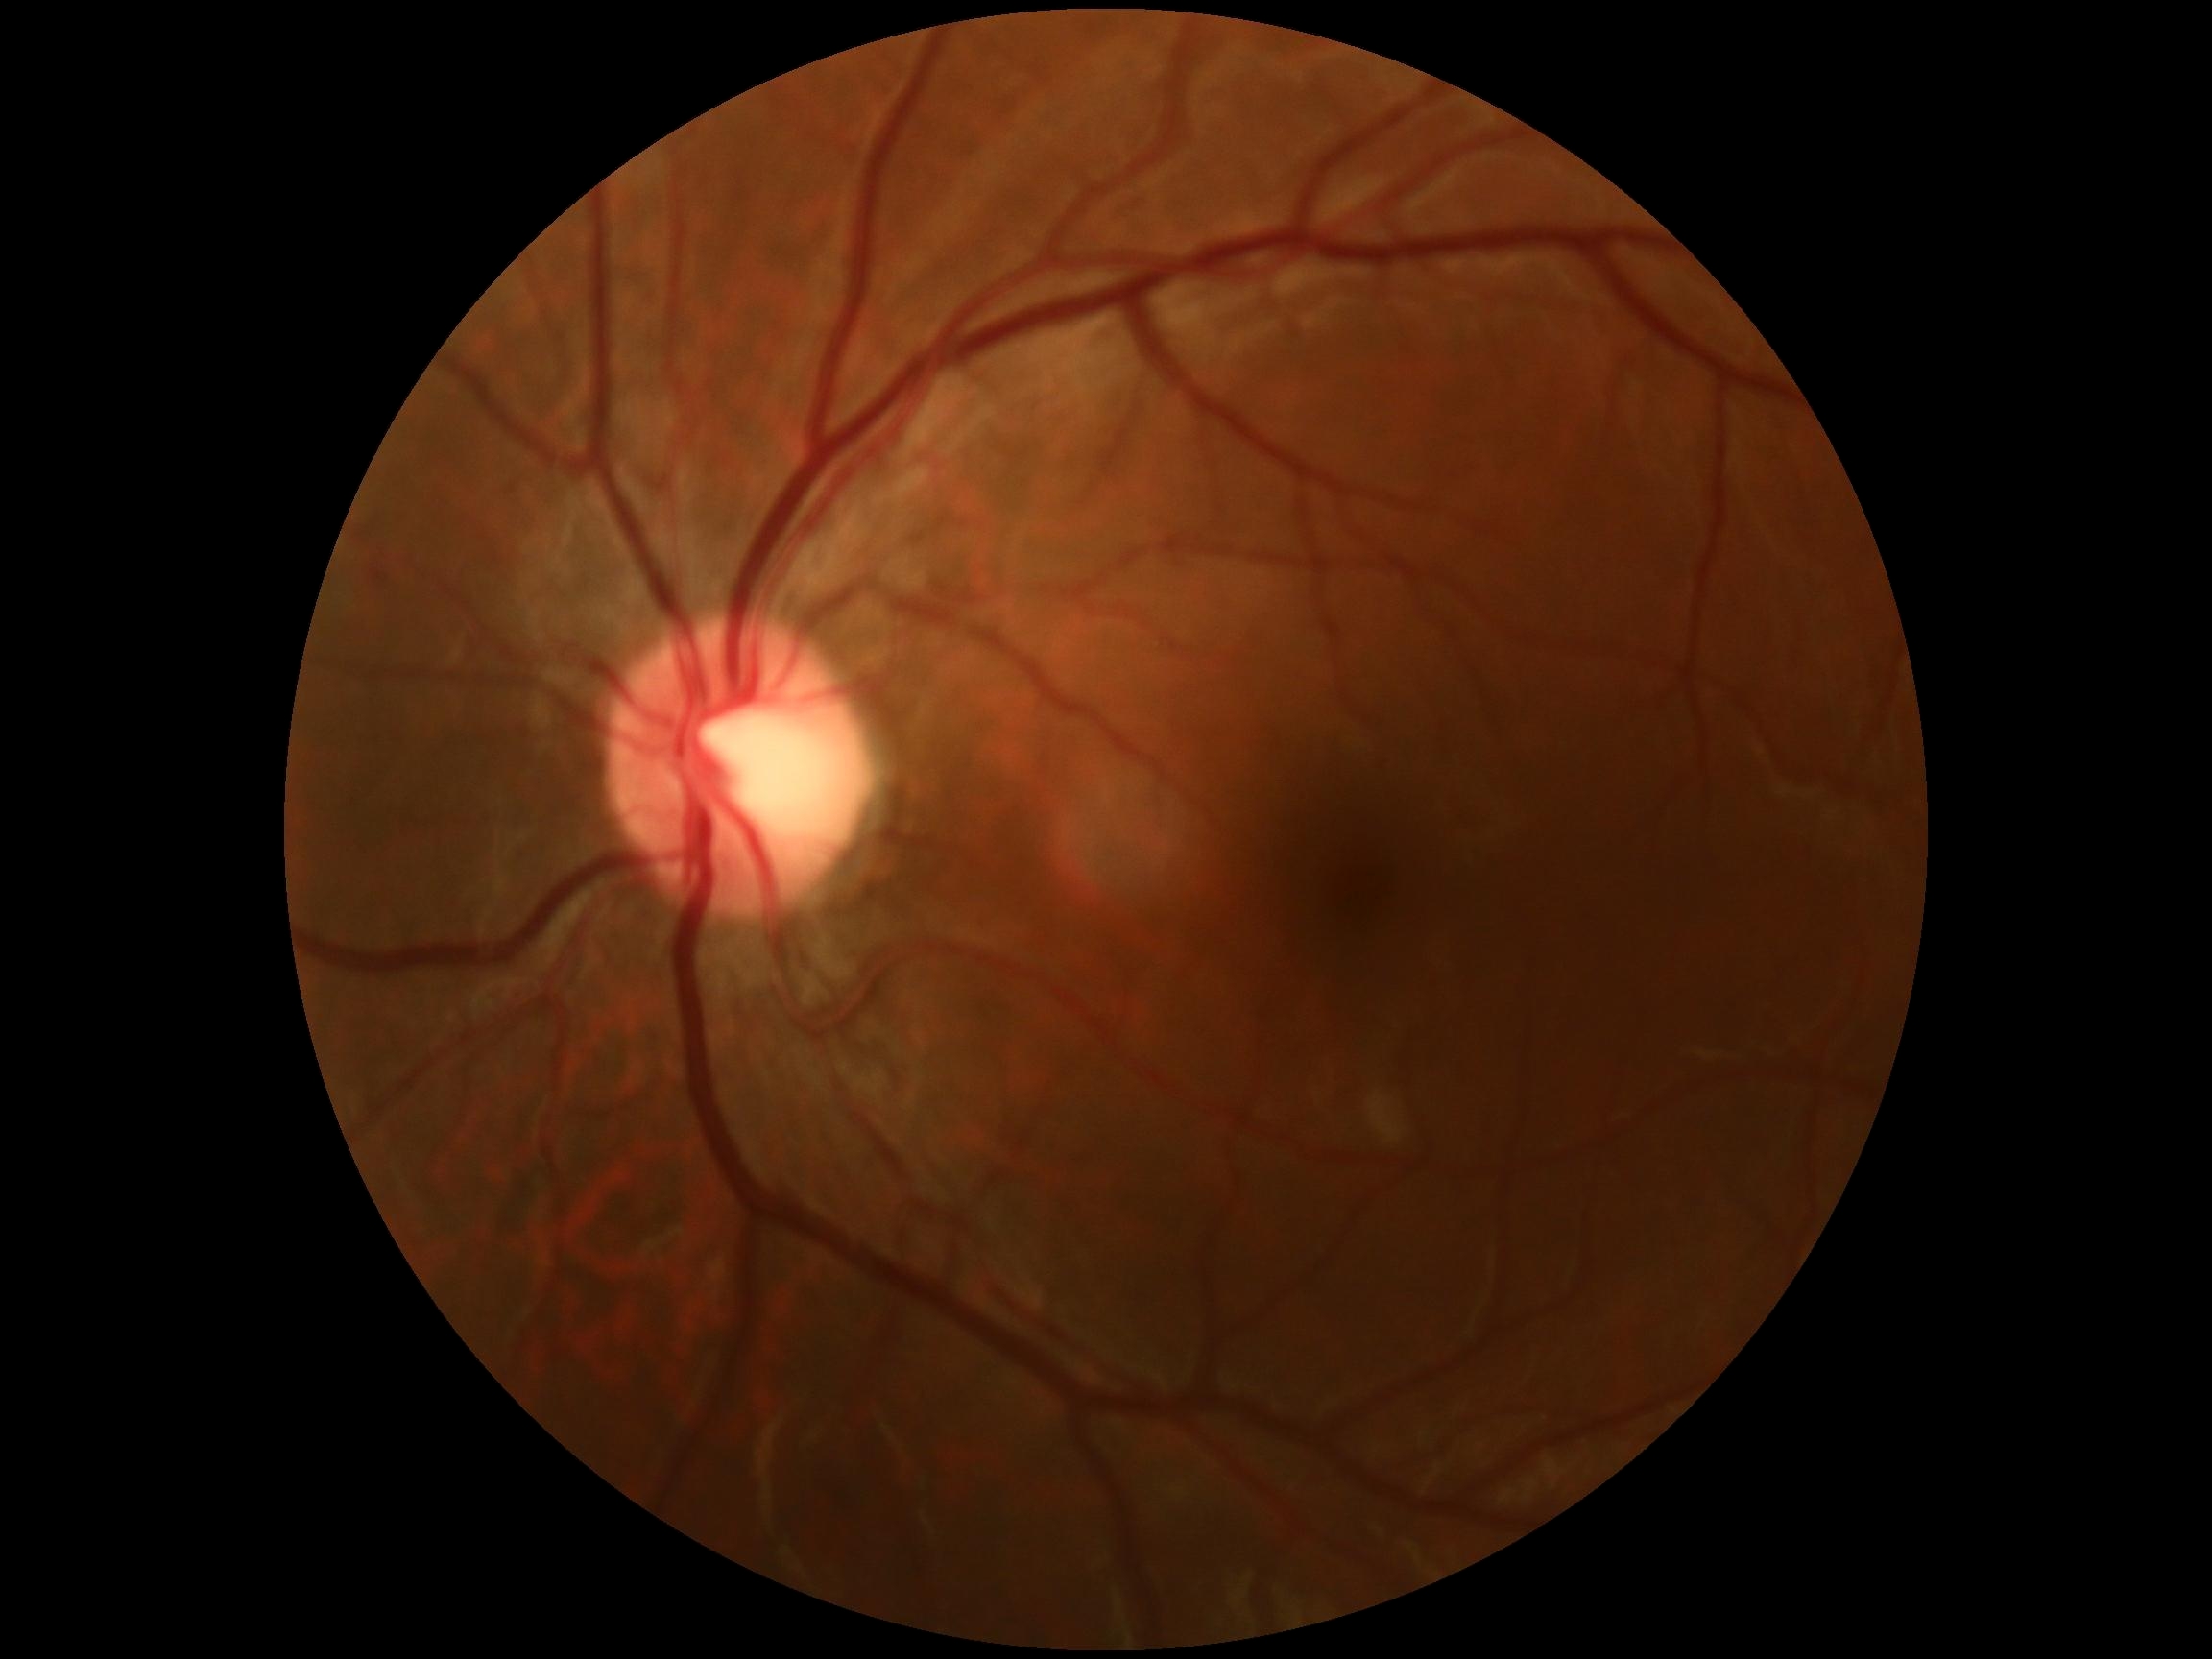

Retinopathy is grade 0 (no apparent retinopathy) — no visible signs of diabetic retinopathy.